Infant wide-field fundus photograph.
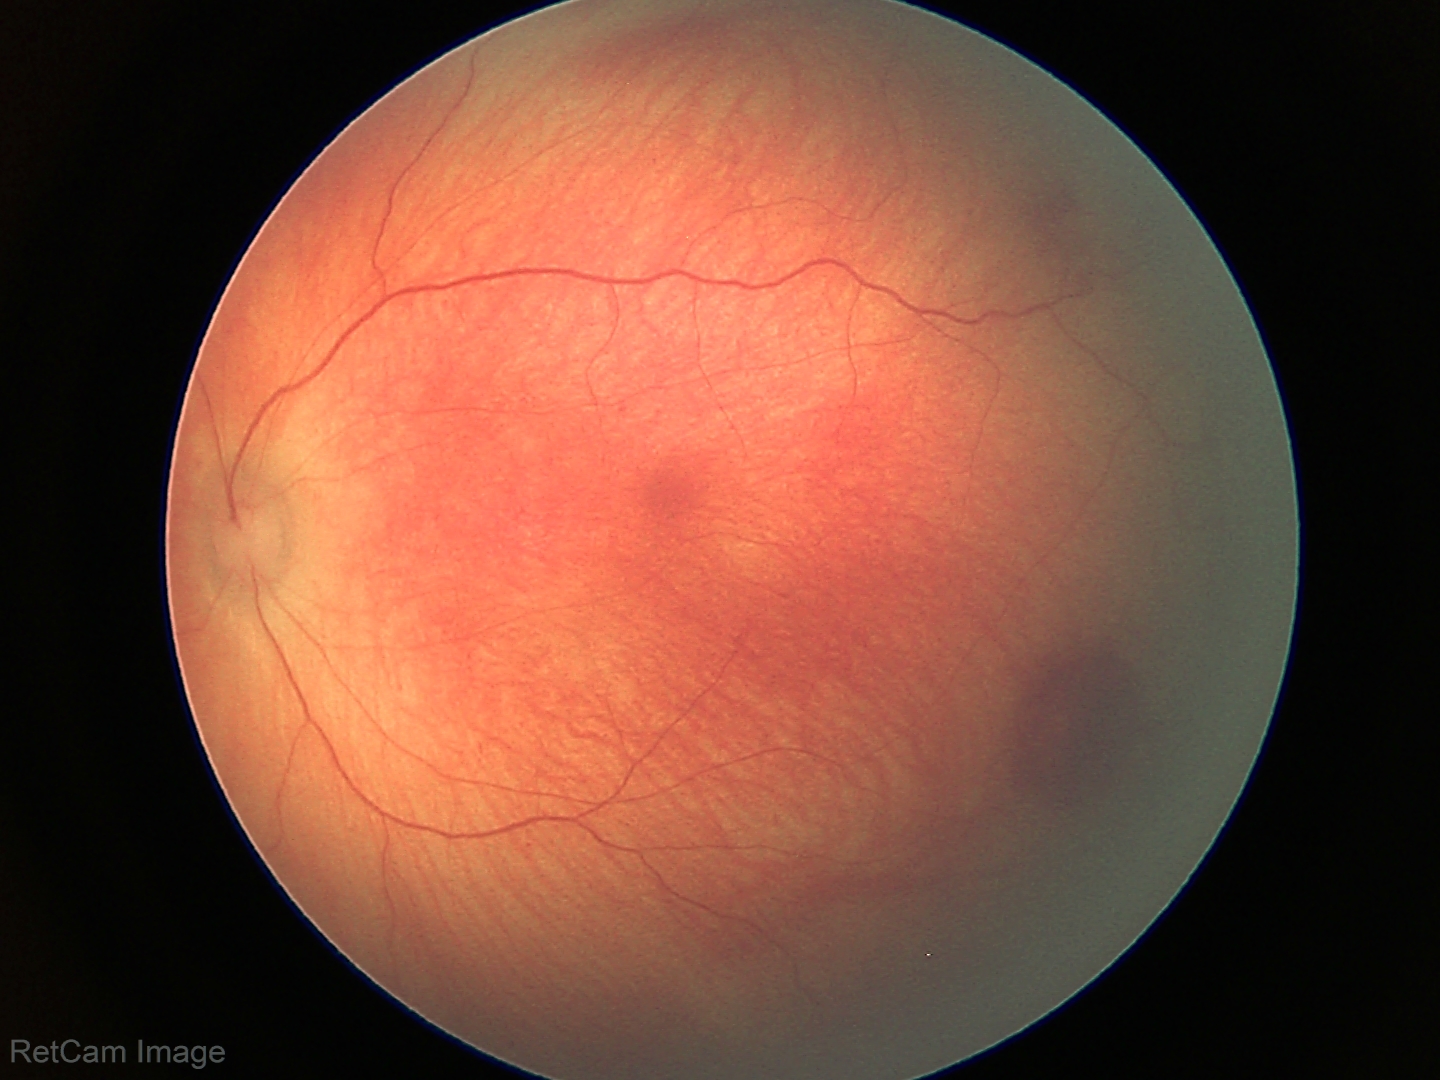
Examination diagnosed as retinal hemorrhages.